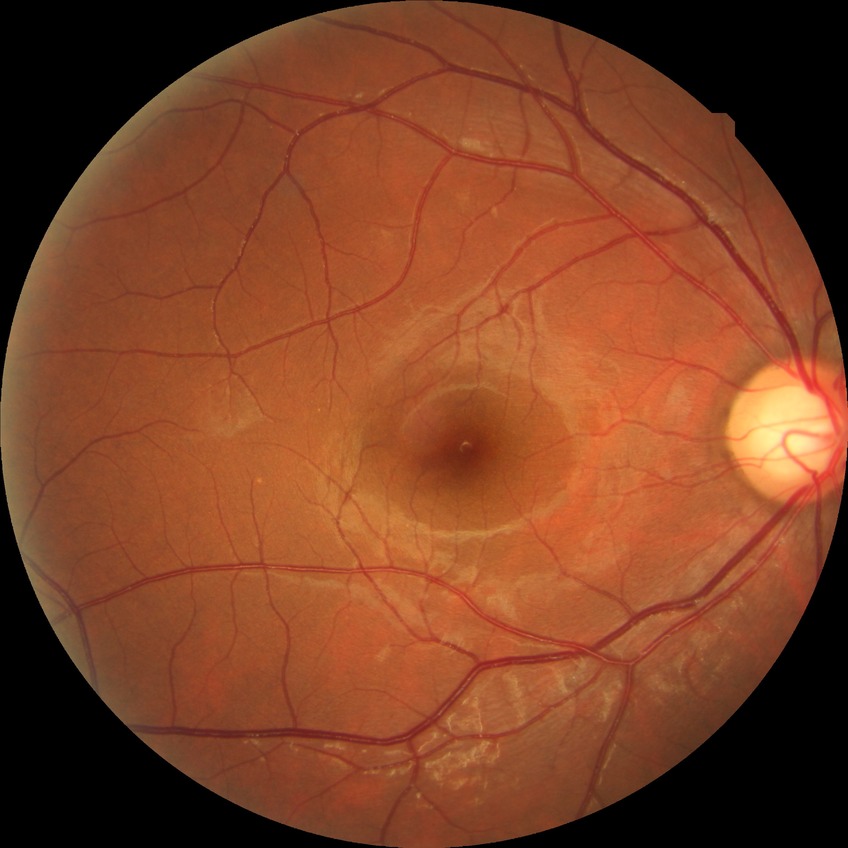

diabetic retinopathy stage@no diabetic retinopathy.